Fundus photo, 1970 by 1876 pixels
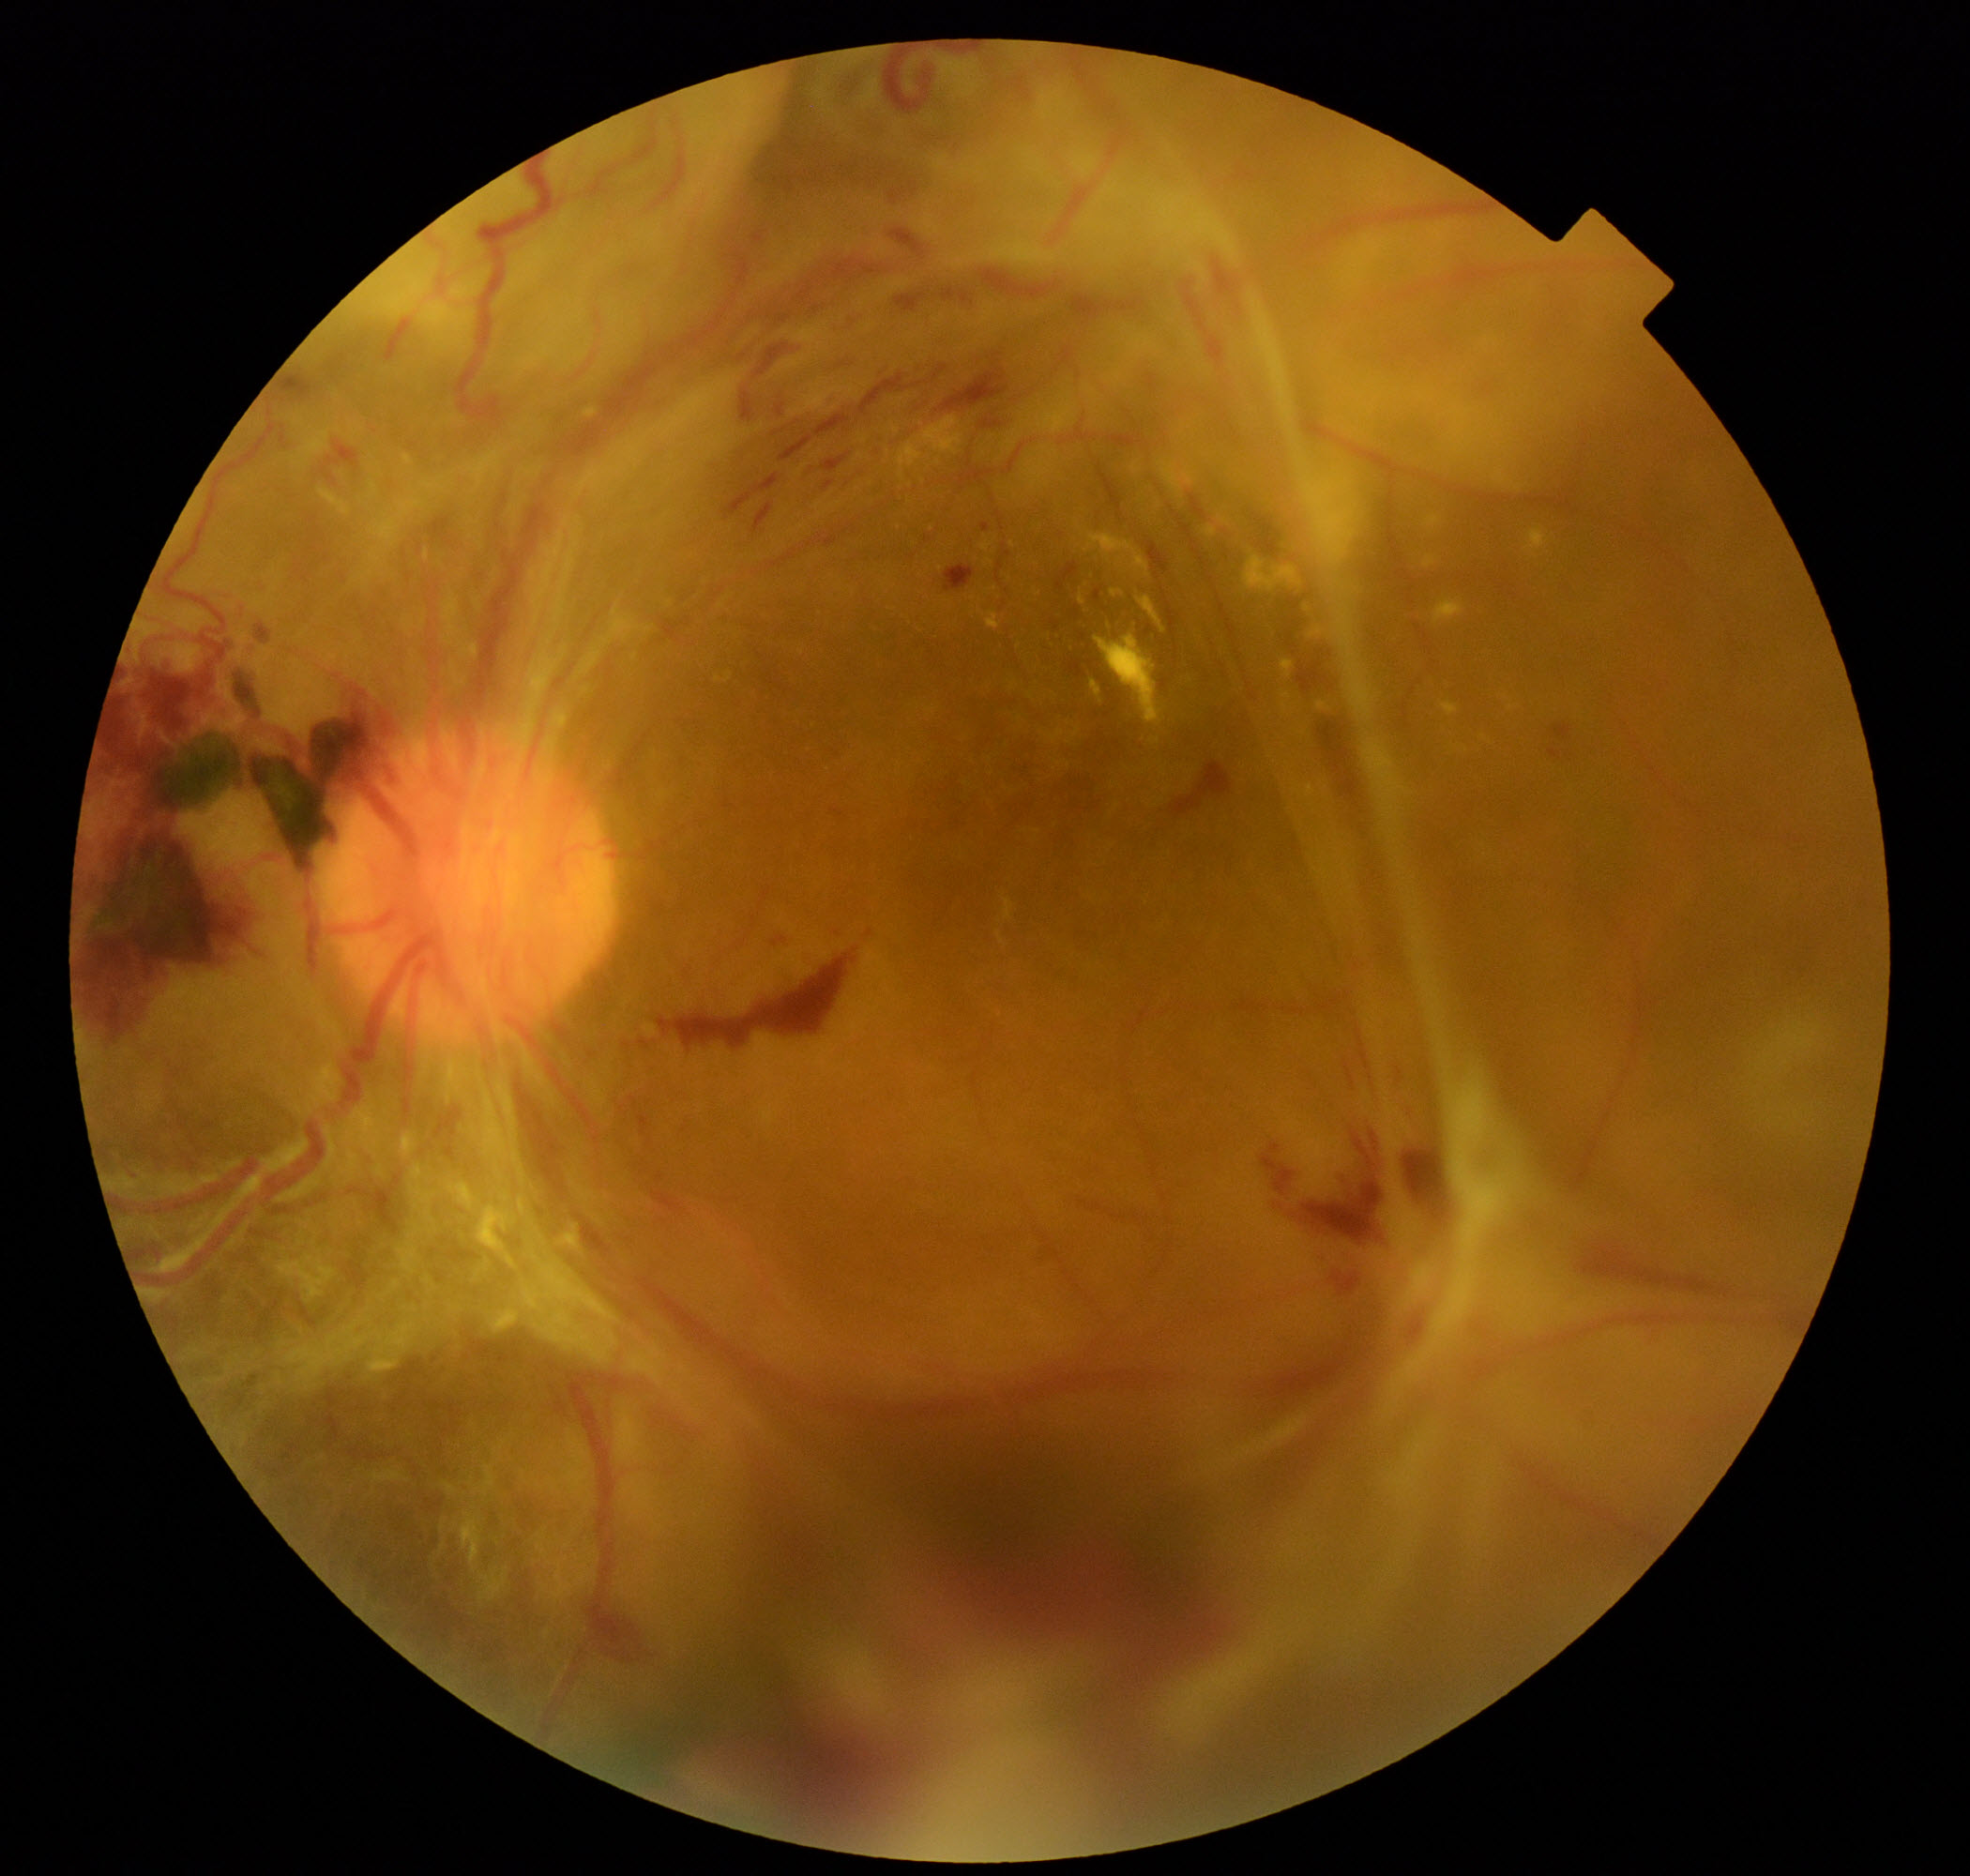

Diagnosis: severe non-proliferative or proliferative diabetic retinopathy.